Acquired with a NIDEK AFC-230. CFP. Nonmydriatic. 45 degree fundus photograph — 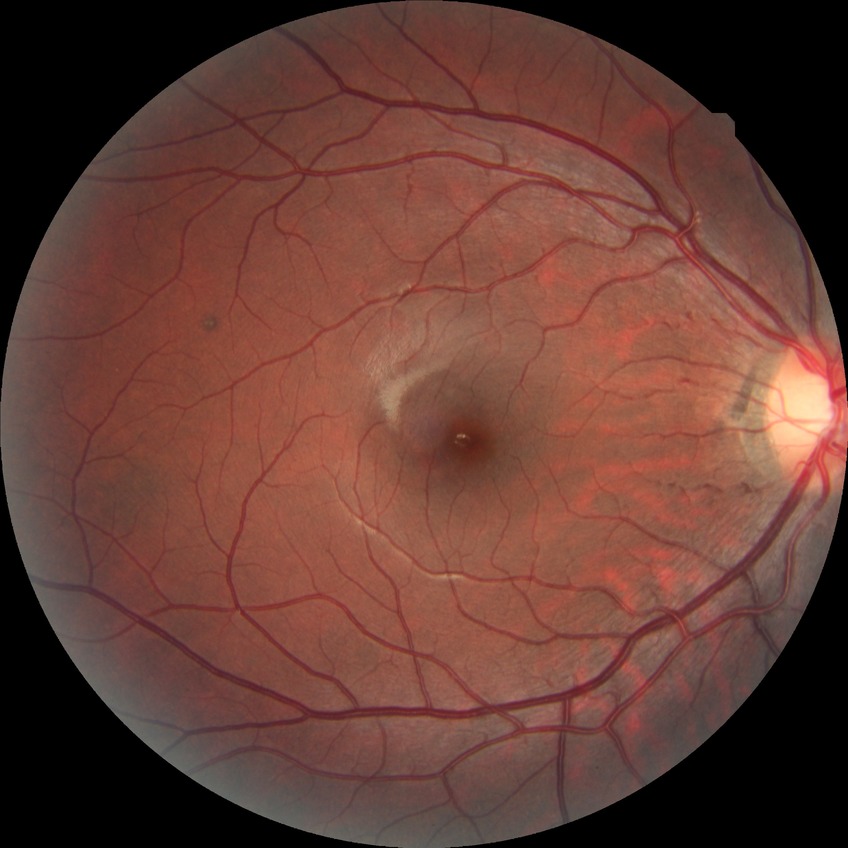
Davis grading: no diabetic retinopathy.